Without pupil dilation — 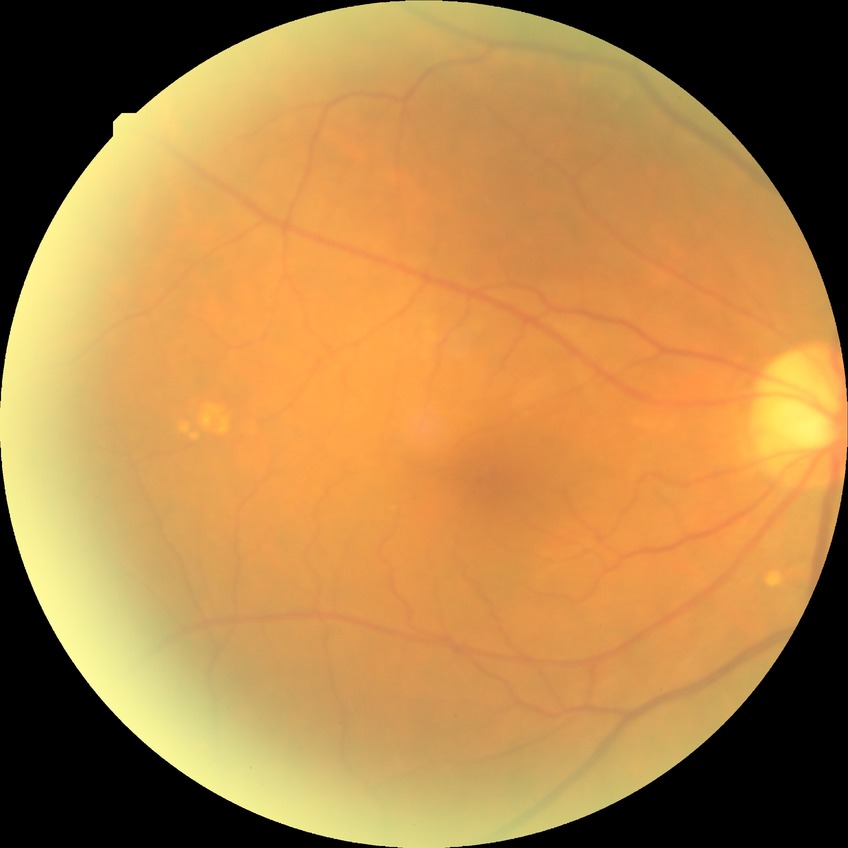
Diabetic retinopathy (DR) is NDR (no diabetic retinopathy).